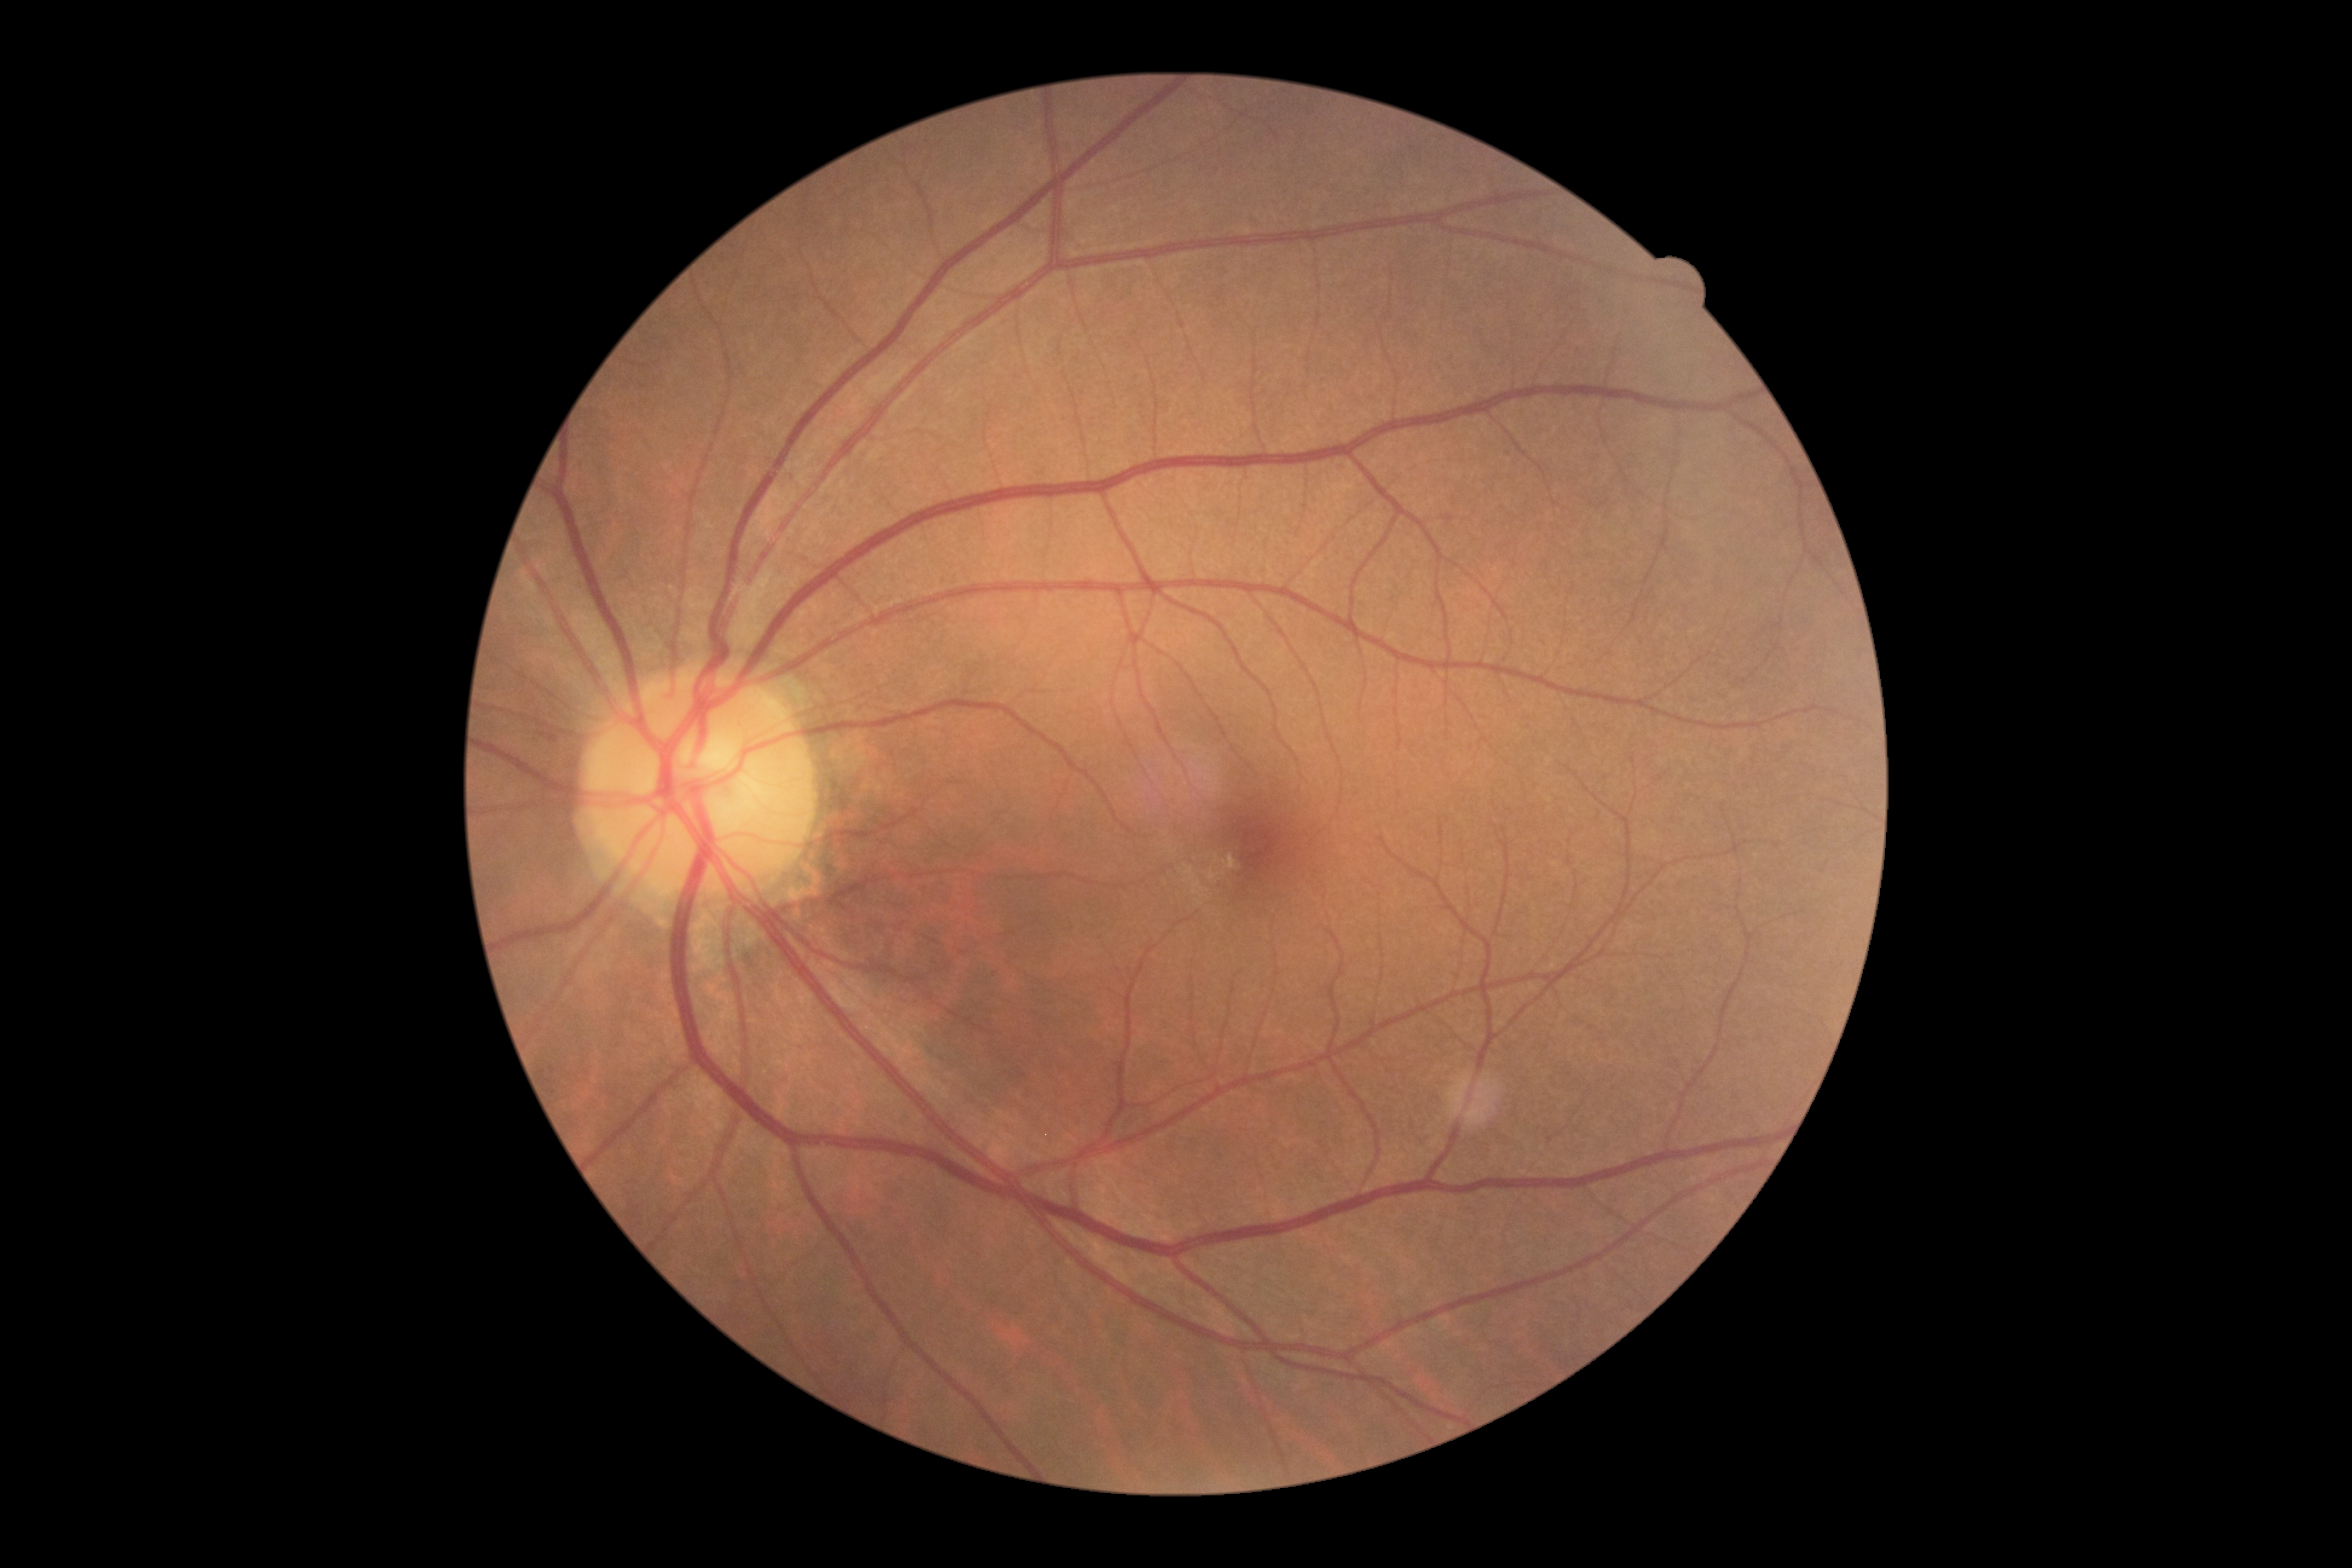

Diabetic retinopathy grade is 0 (no apparent retinopathy). No apparent diabetic retinopathy.